Graded on the modified Davis scale, 45° field of view
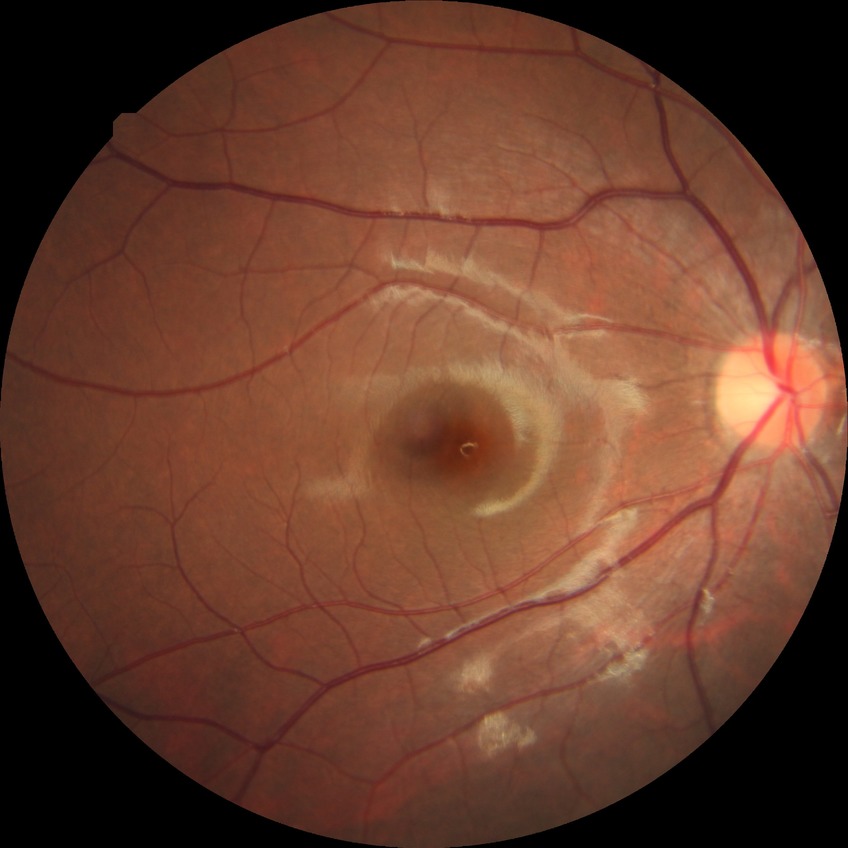
Modified Davis grading: no diabetic retinopathy.